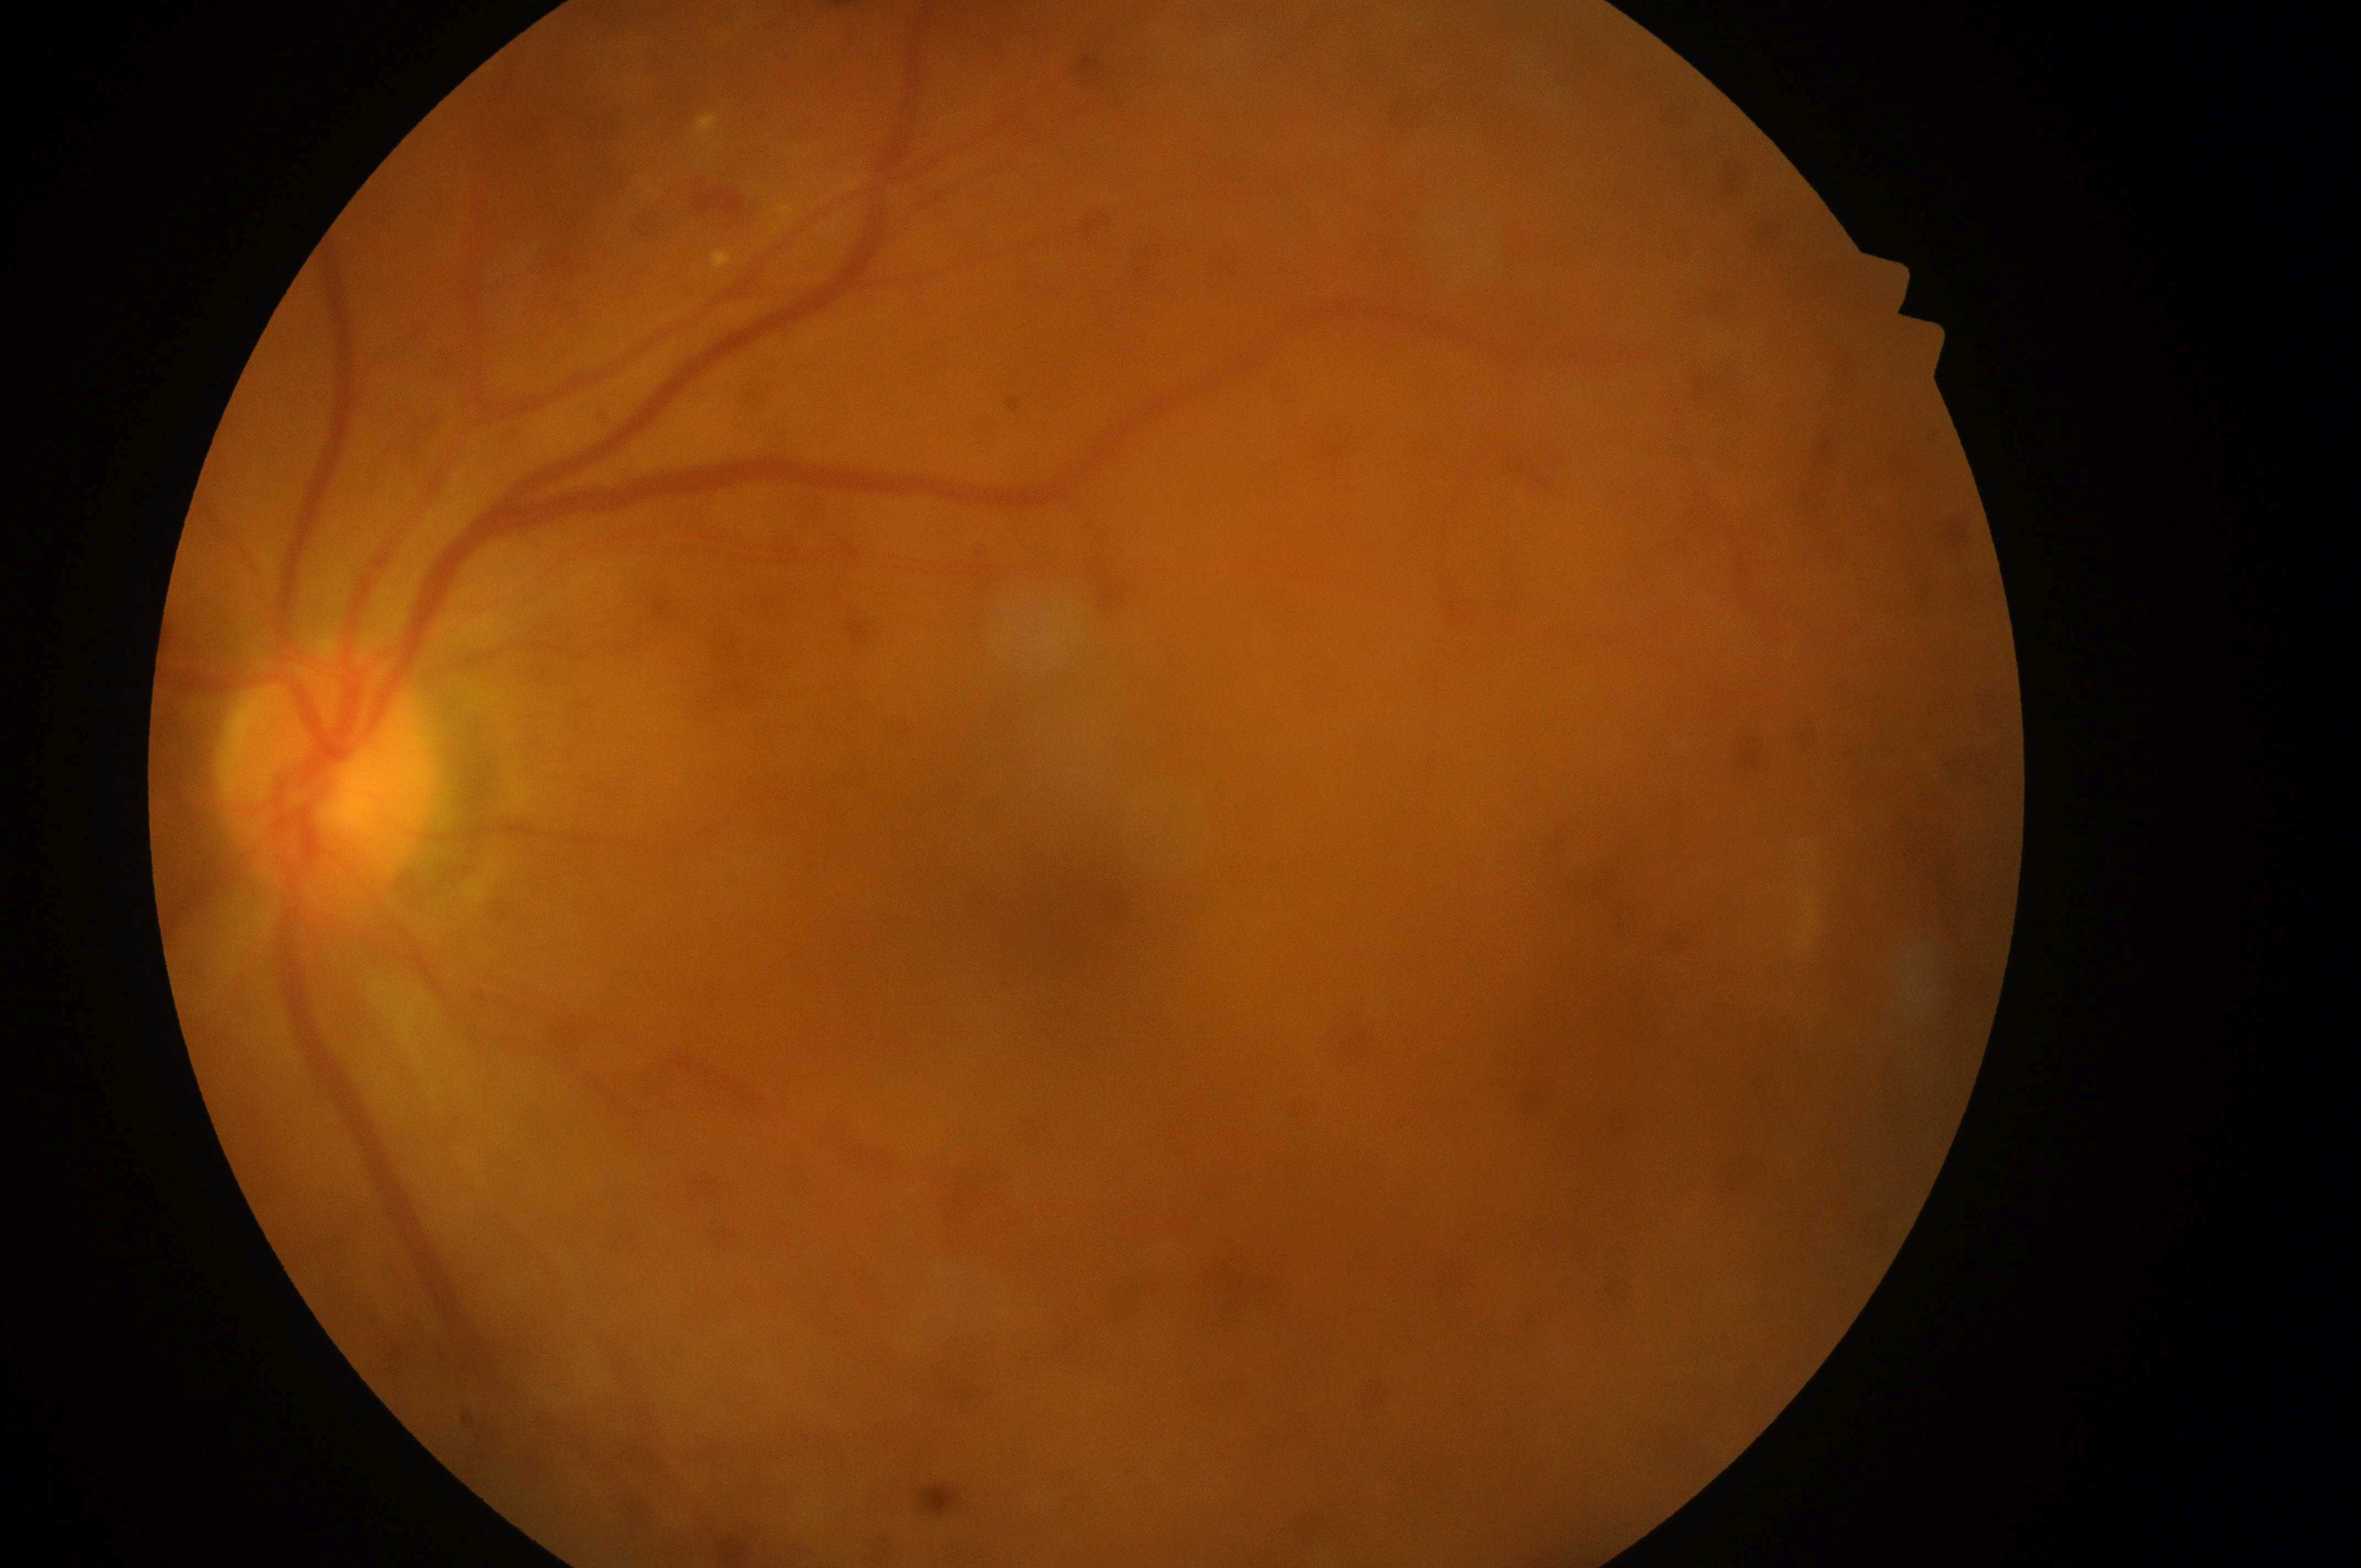
The optic disc center is at 319, 785.
Imaged eye: the left eye.
DR severity: moderate non-proliferative diabetic retinopathy (grade 2).
Fovea center located at 1068, 907.
DME grade: low risk (1).